2212 by 1659 pixels. Fundus photo — 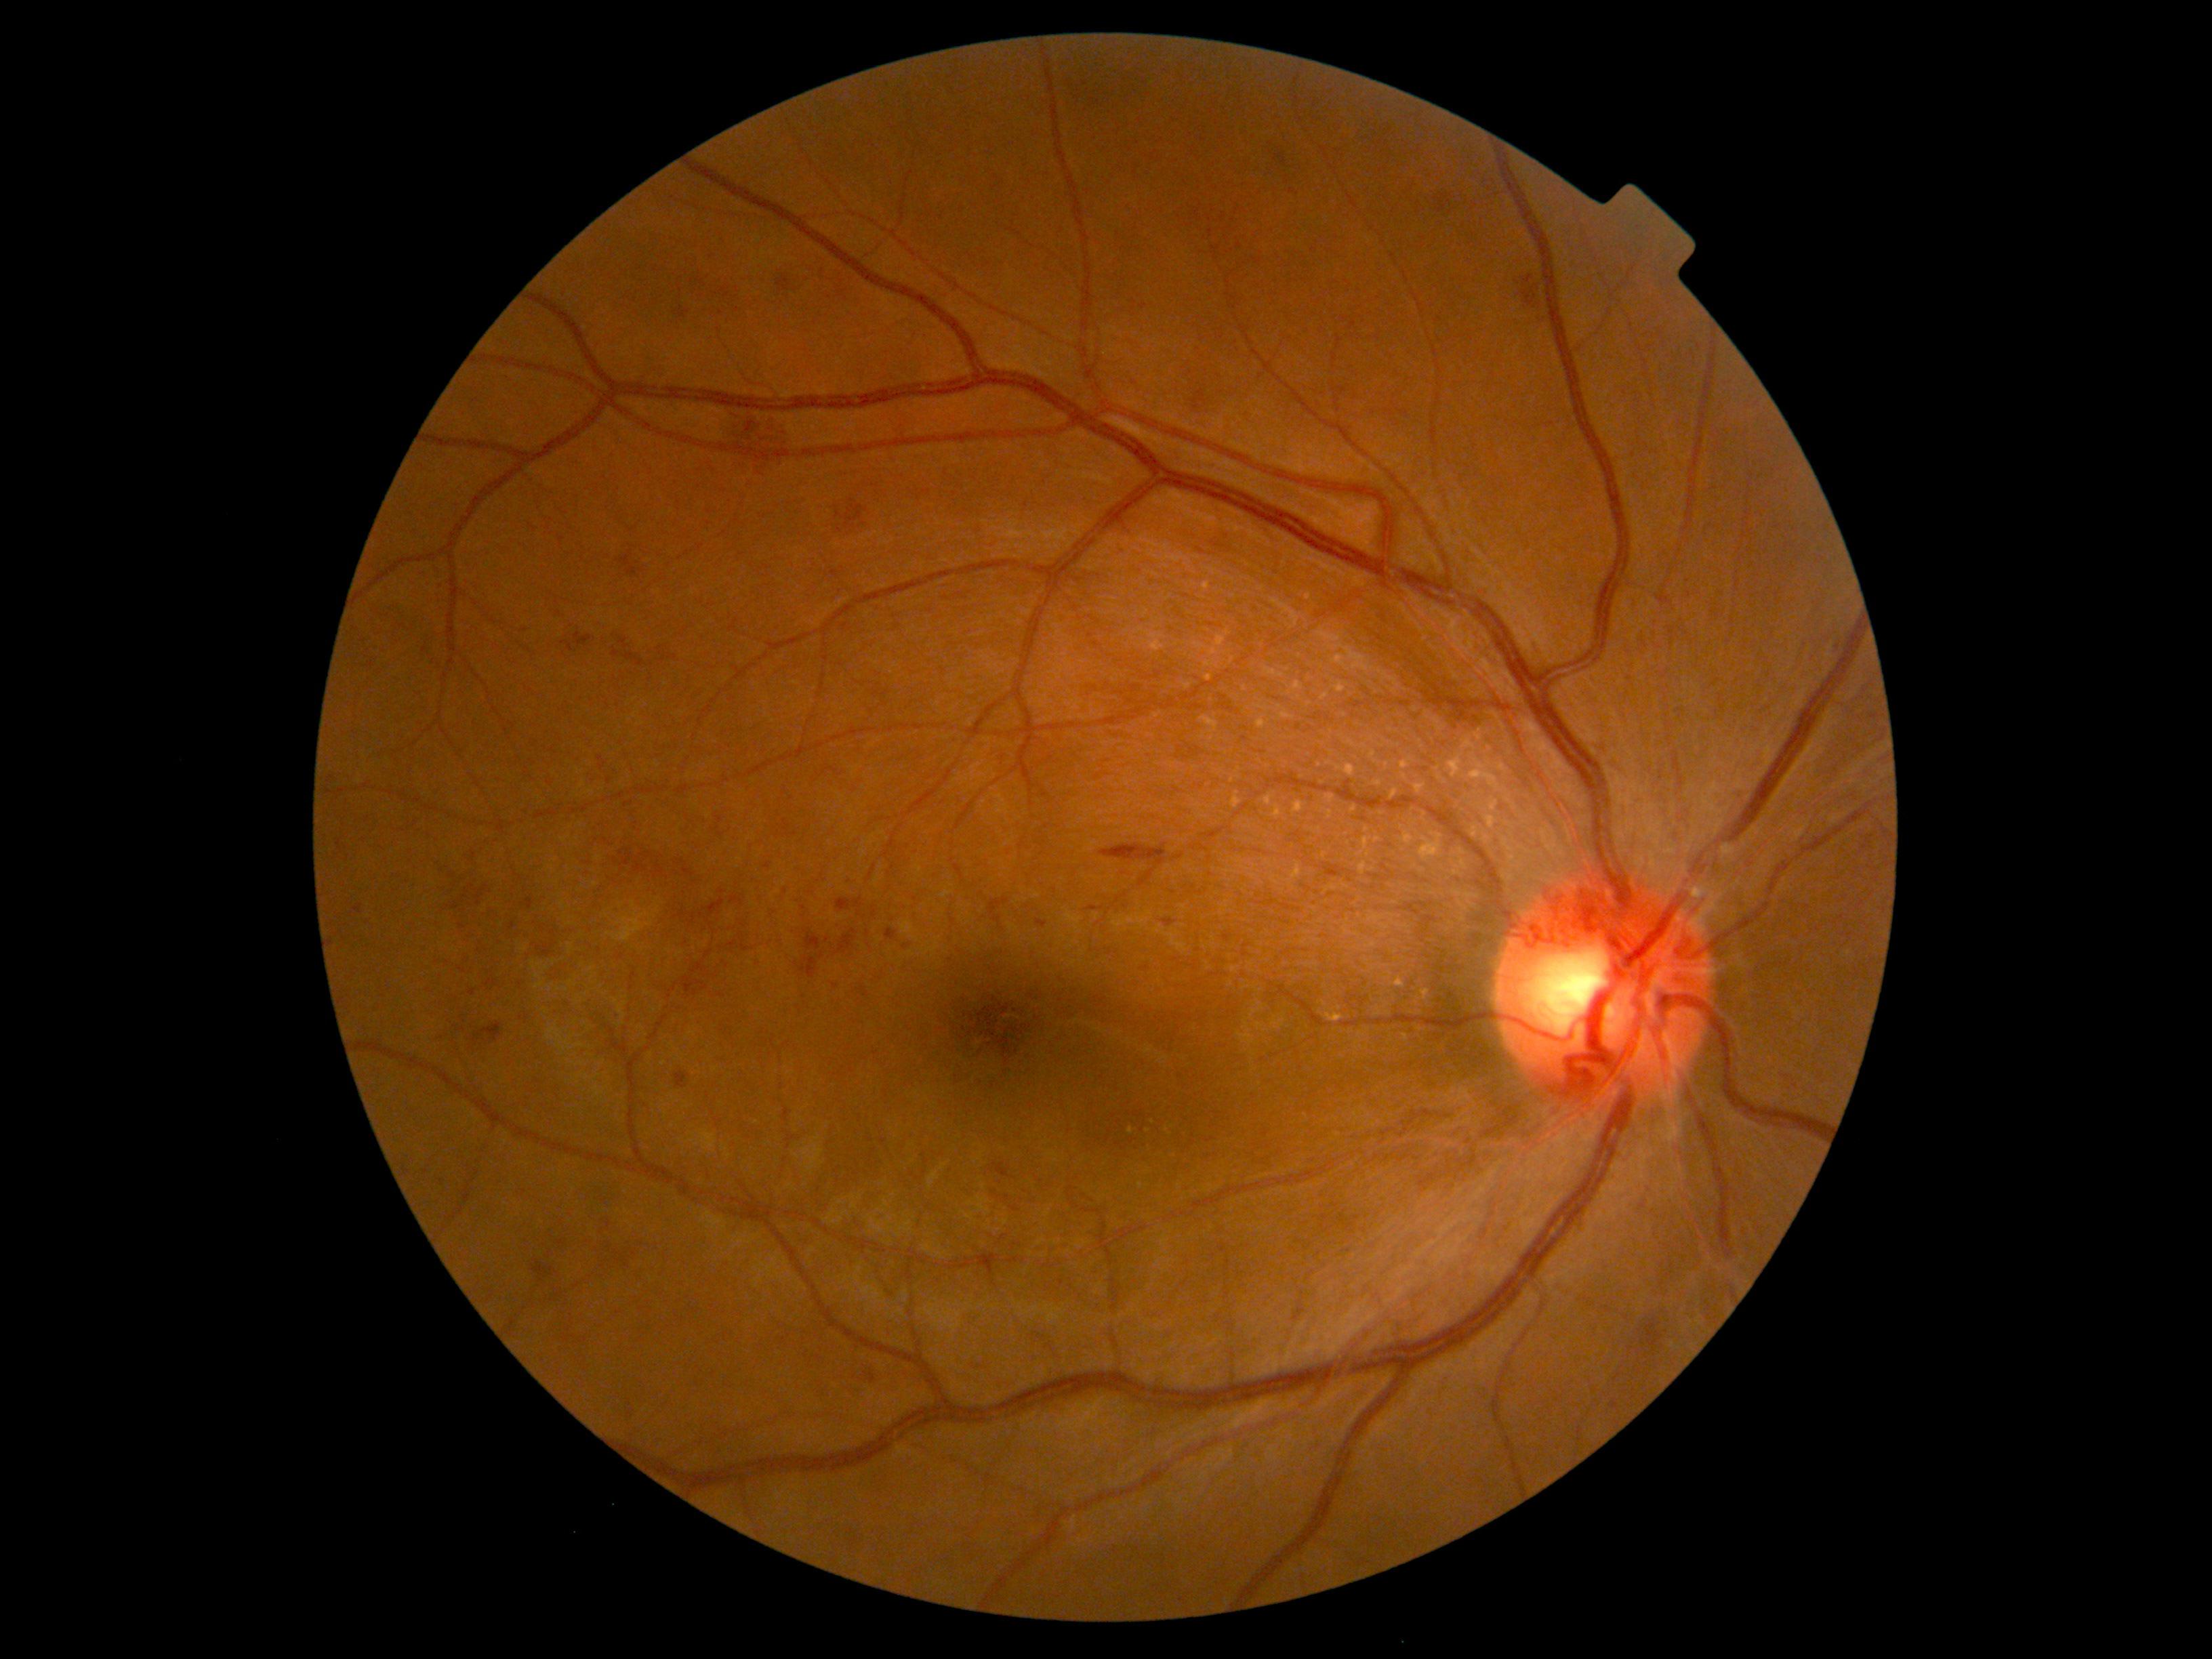

DR stage is grade 2 (moderate NPDR). HEs include {"left": 859, "top": 986, "right": 869, "bottom": 1000} | {"left": 804, "top": 930, "right": 821, "bottom": 951} | {"left": 337, "top": 840, "right": 342, "bottom": 851} | {"left": 1212, "top": 541, "right": 1226, "bottom": 548} | {"left": 468, "top": 990, "right": 476, "bottom": 996} | {"left": 1100, "top": 842, "right": 1168, "bottom": 865} | {"left": 777, "top": 274, "right": 792, "bottom": 293} | {"left": 653, "top": 863, "right": 665, "bottom": 876} | {"left": 613, "top": 649, "right": 621, "bottom": 658} | {"left": 783, "top": 1109, "right": 792, "bottom": 1122} | {"left": 800, "top": 956, "right": 818, "bottom": 979} | {"left": 532, "top": 1260, "right": 556, "bottom": 1283}. HEs (small, approximate centers) near 513:926 | 462:926 | 758:965 | 973:1365 | 524:632 | 893:866.